Color fundus image, 45 degree fundus photograph, acquired with a NIDEK AFC-230:
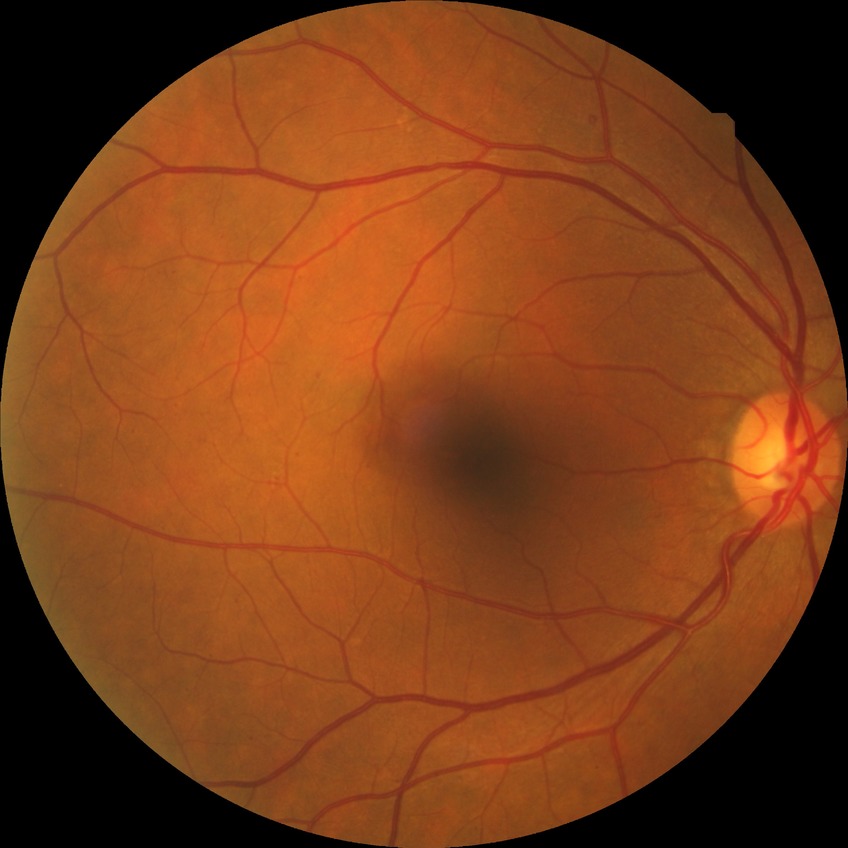 Diabetic retinopathy severity: simple diabetic retinopathy.